DR severity per modified Davis staging
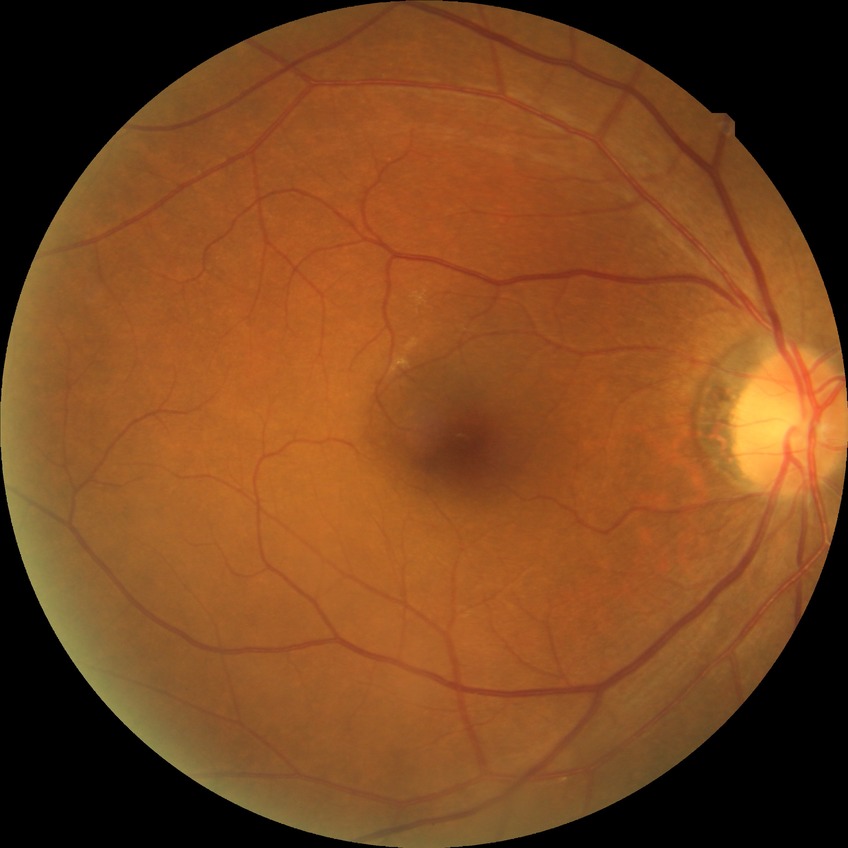

{
  "davis_grade": "no diabetic retinopathy"
}